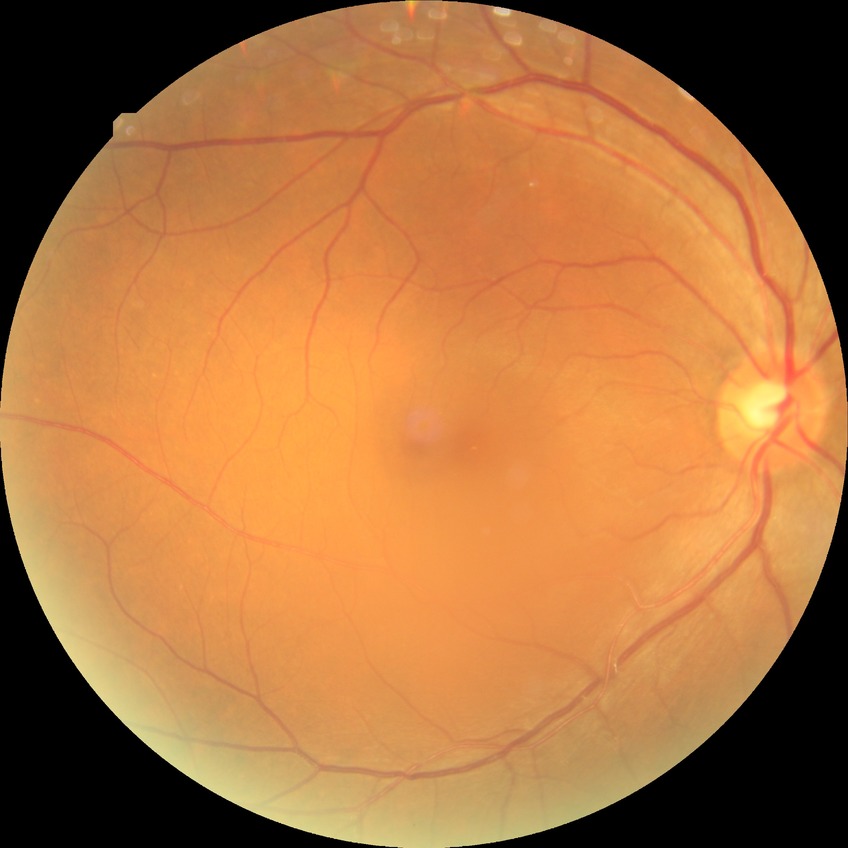 Diabetic retinopathy (DR): NDR (no diabetic retinopathy).